Nonmydriatic:
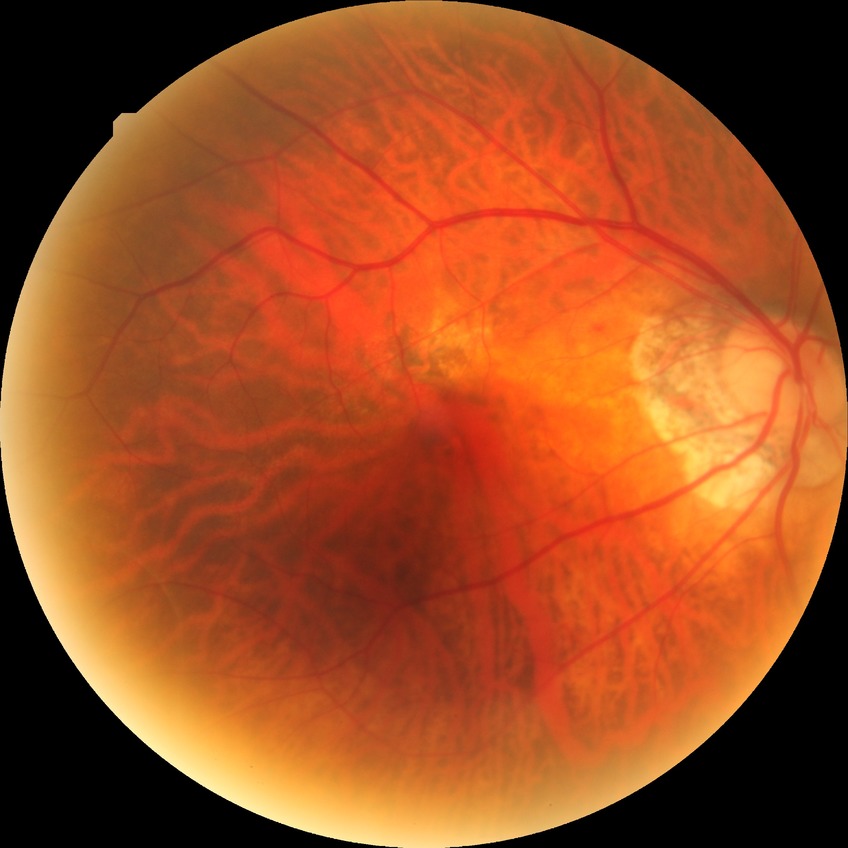 davis_grade: no diabetic retinopathy